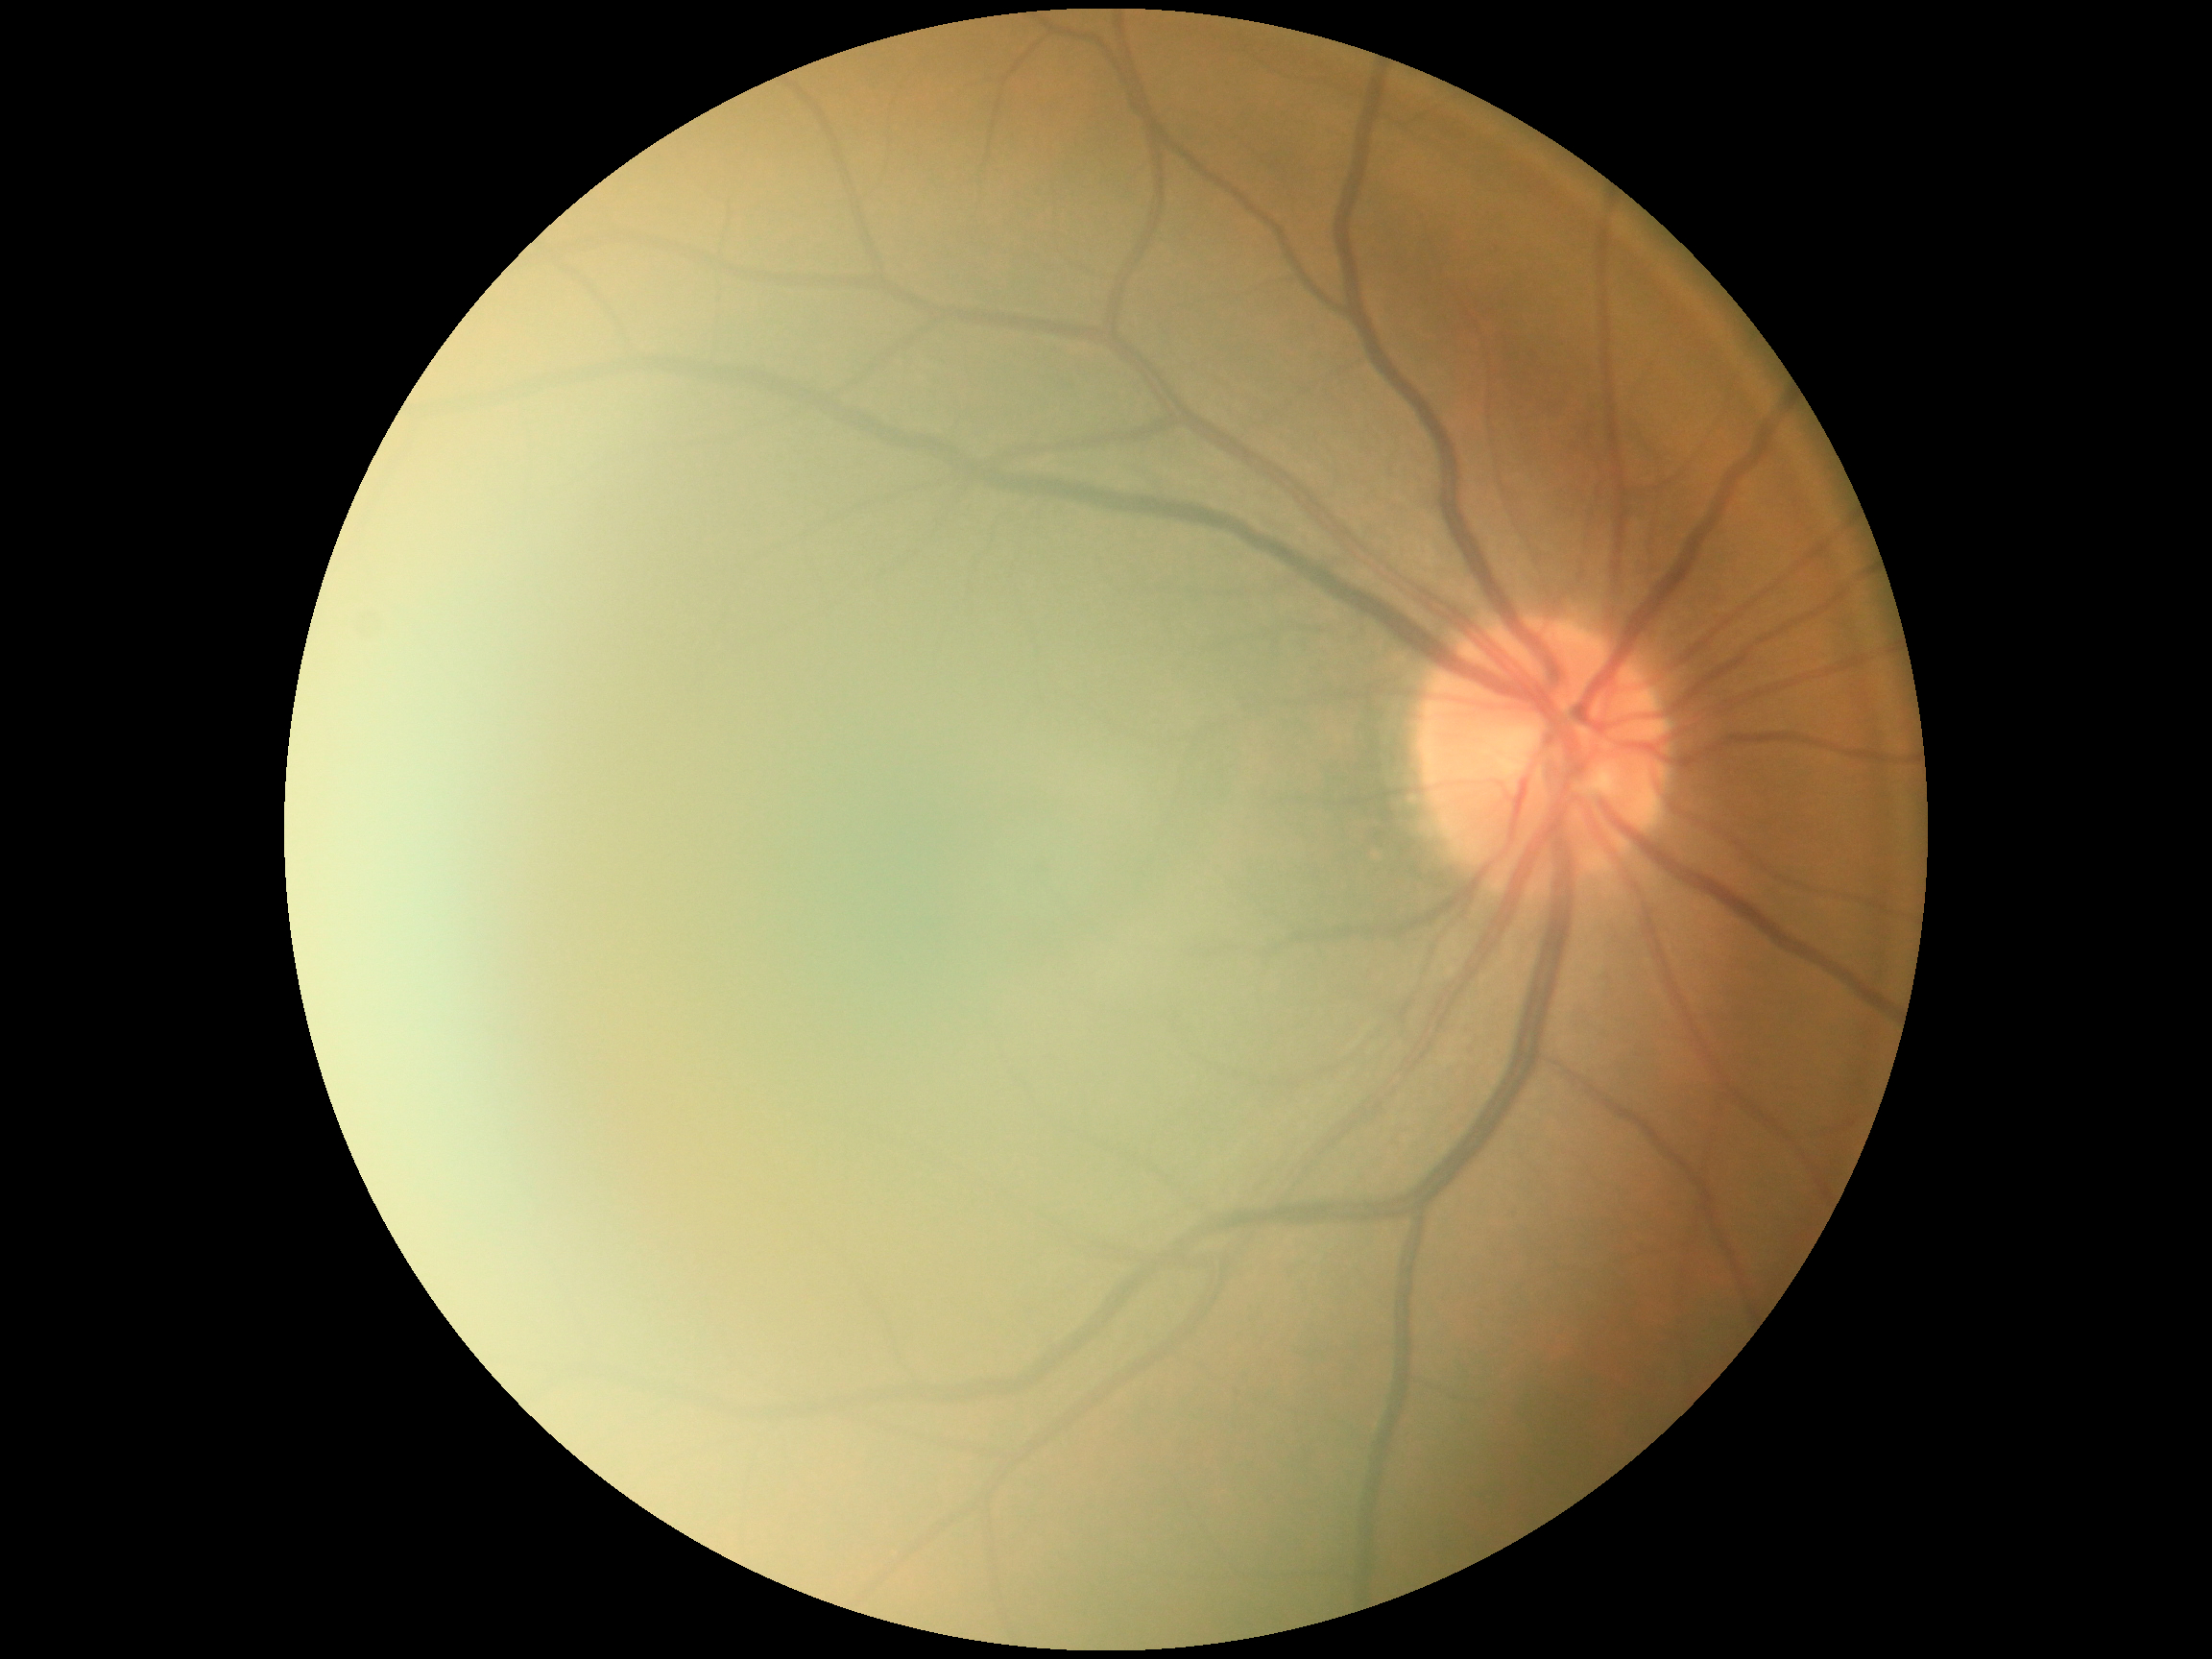
Findings:
– diabetic retinopathy (DR): grade 0 (no apparent retinopathy)
– DR impression: negative for DR